Color fundus photograph; diabetic retinopathy graded by the modified Davis classification: 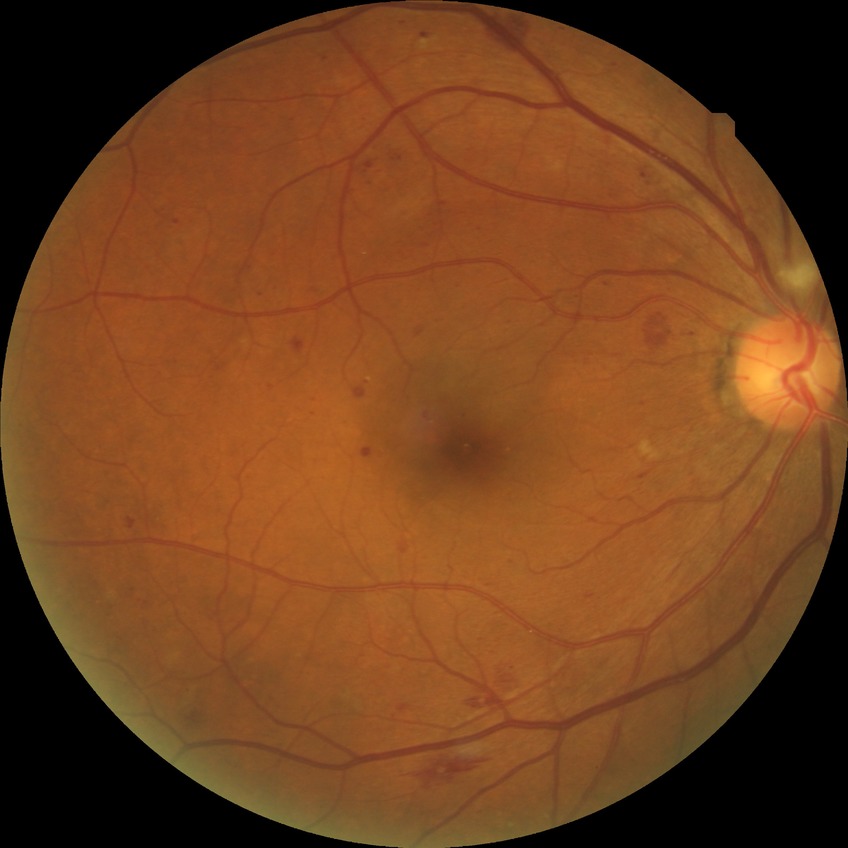
diabetic retinopathy severity: pre-proliferative diabetic retinopathy.